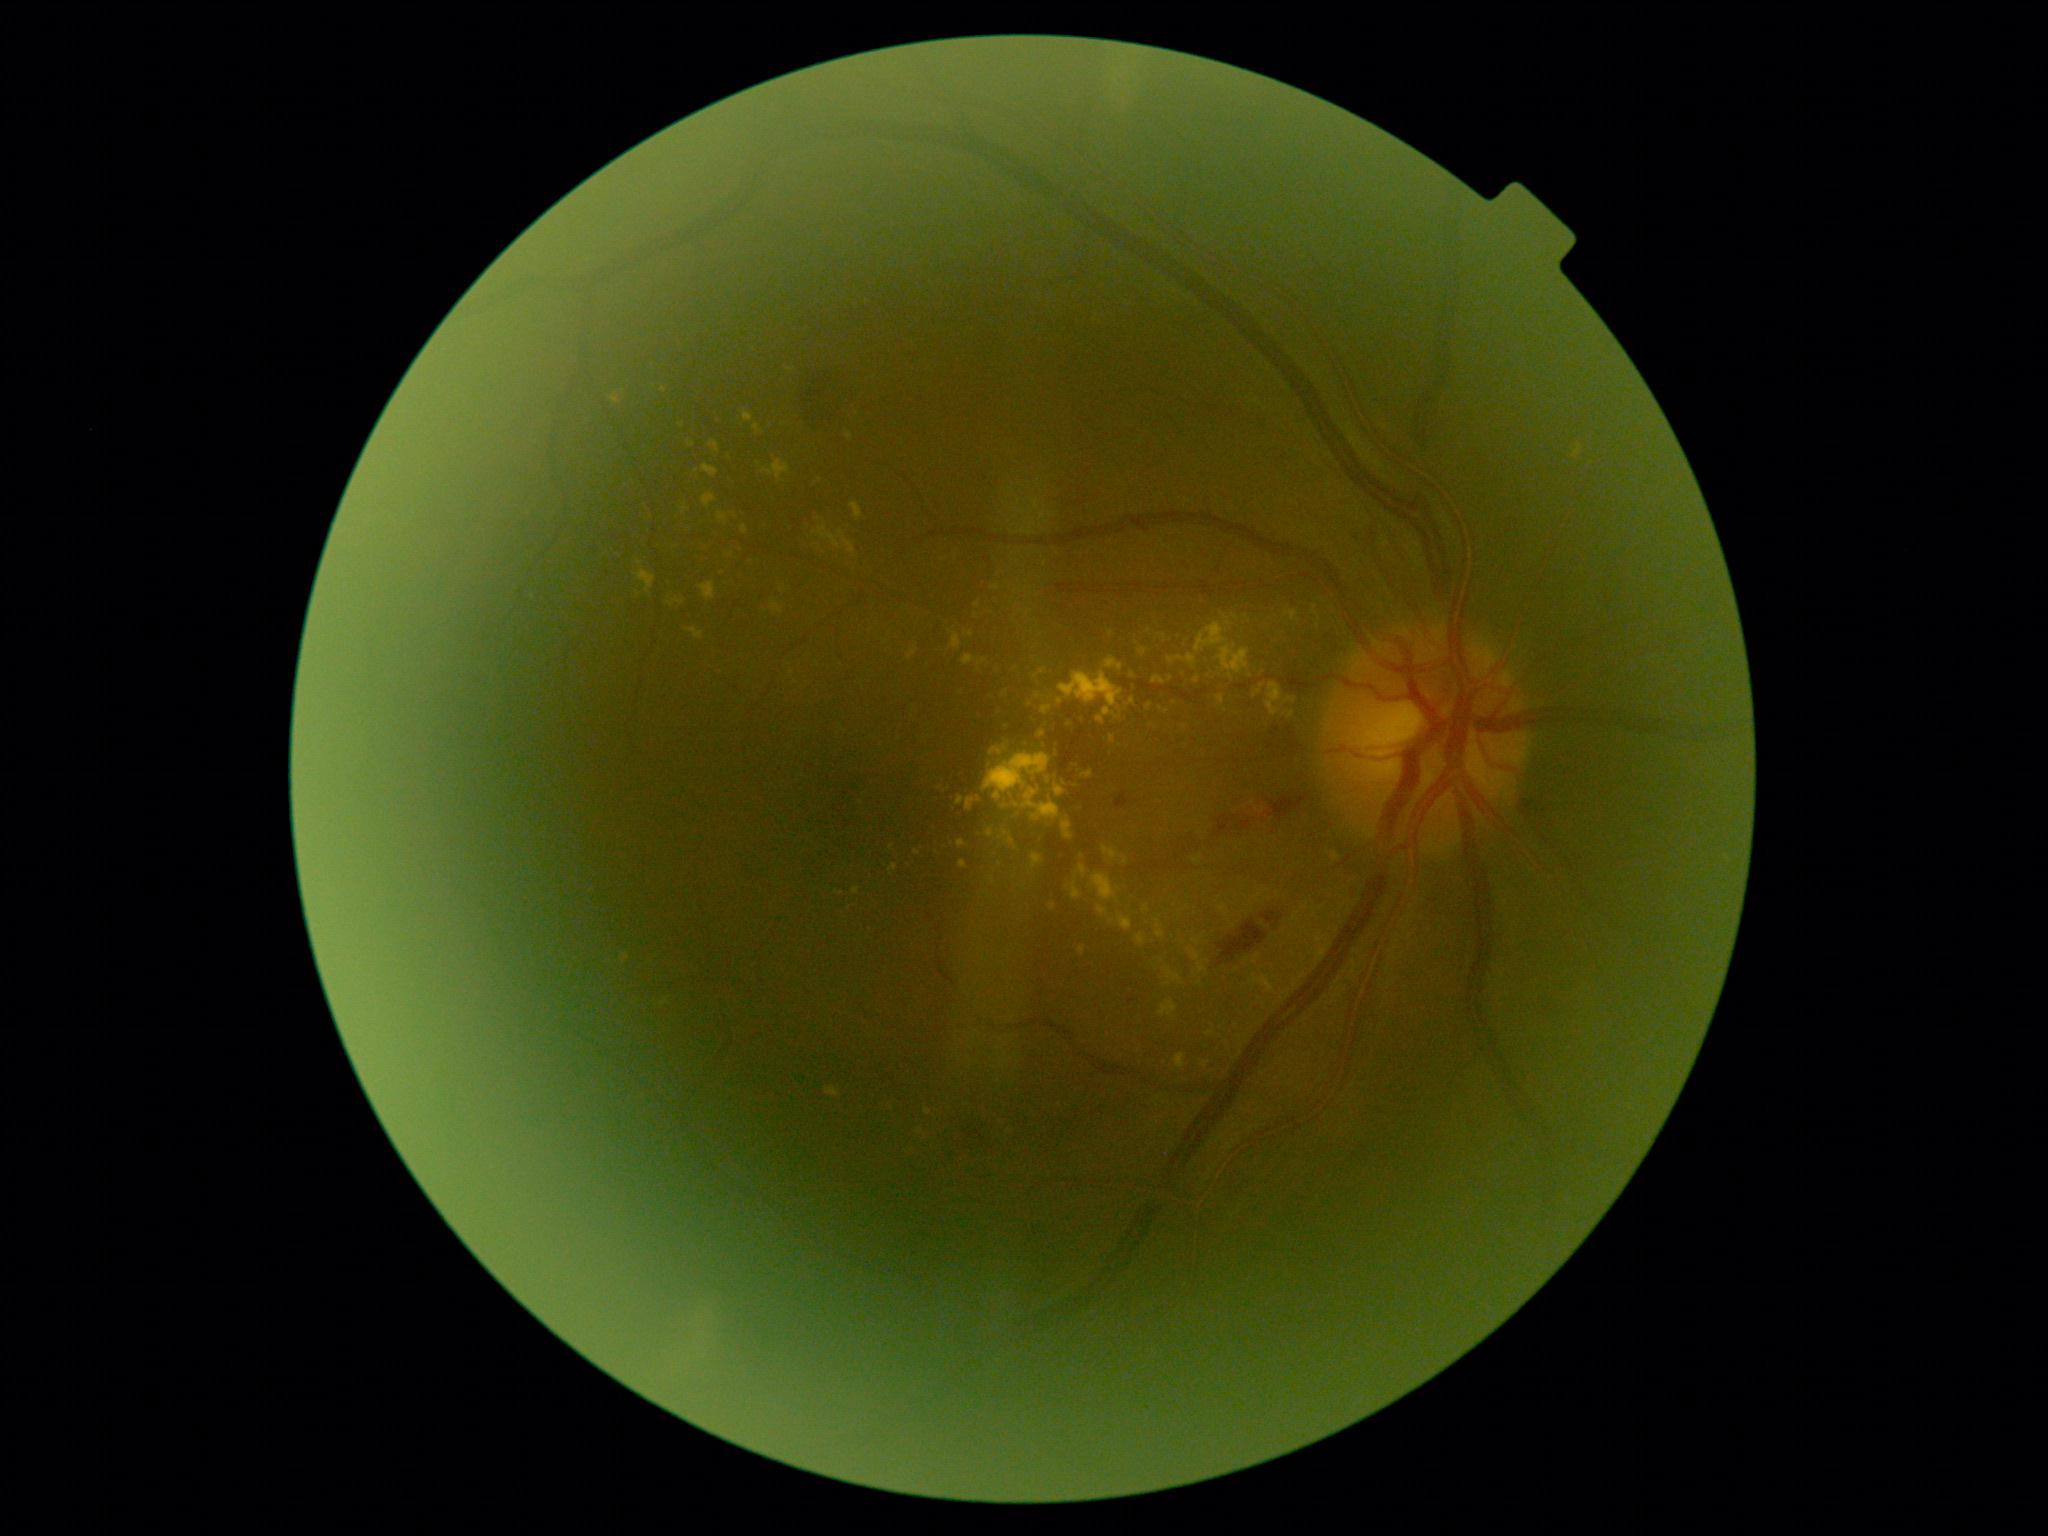
DR class: non-proliferative diabetic retinopathy
DR severity: moderate NPDR (grade 2)